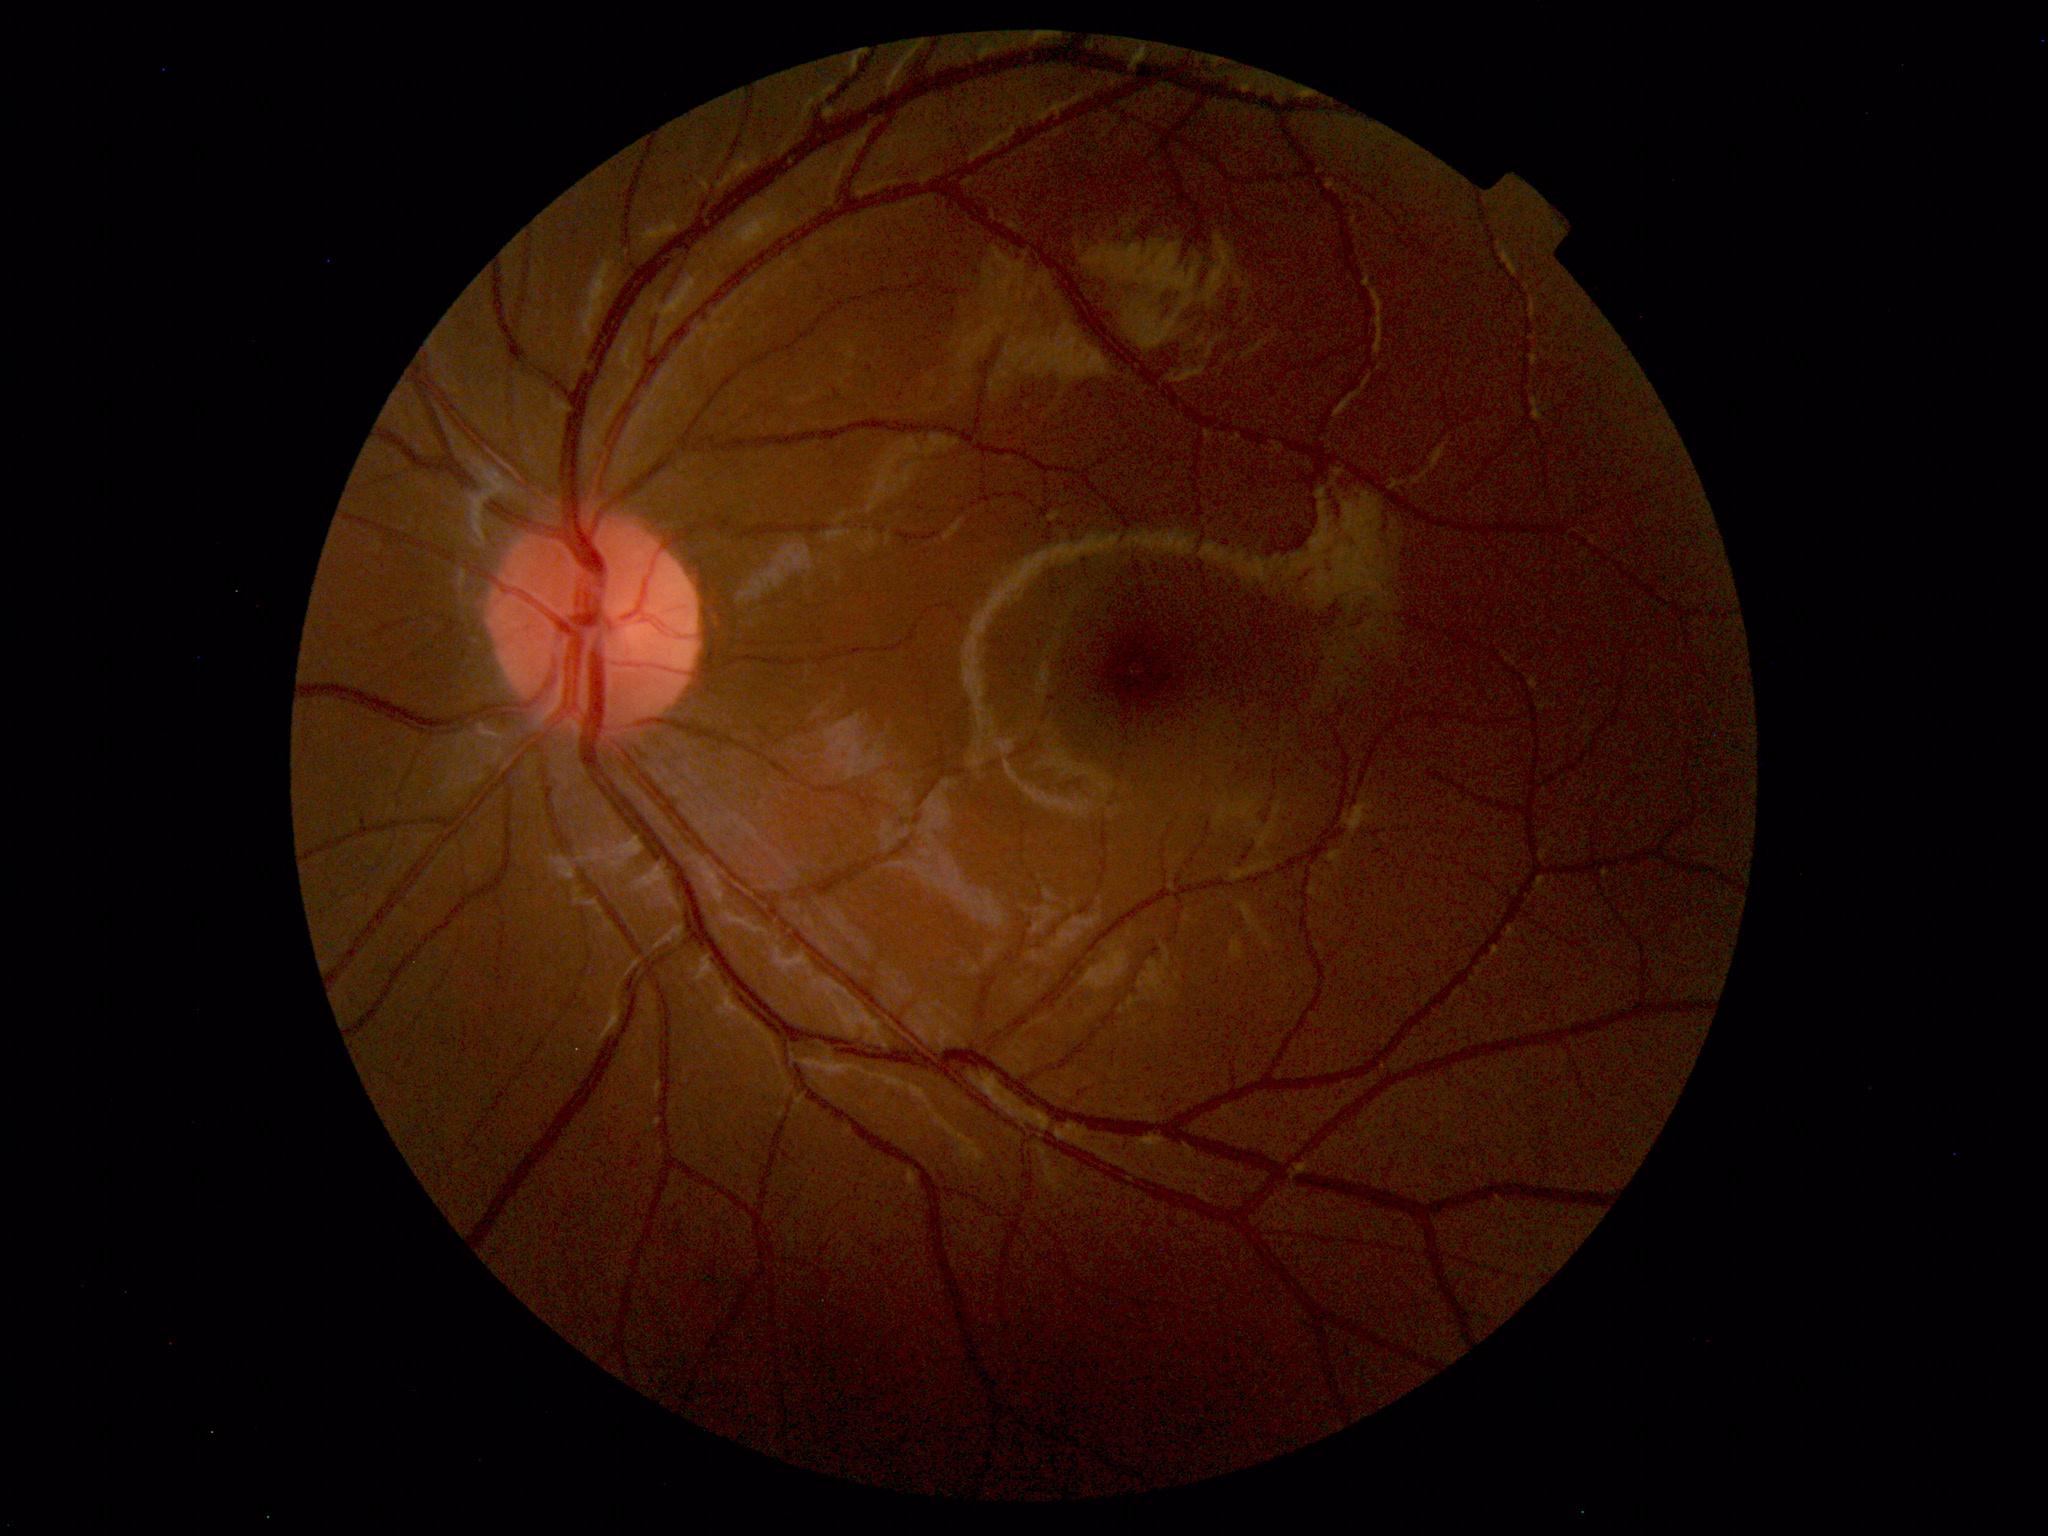

Impression: within normal limits.